Wide-field fundus image from infant ROP screening. Image size 1440x1080. 130° field of view (Natus RetCam Envision) — 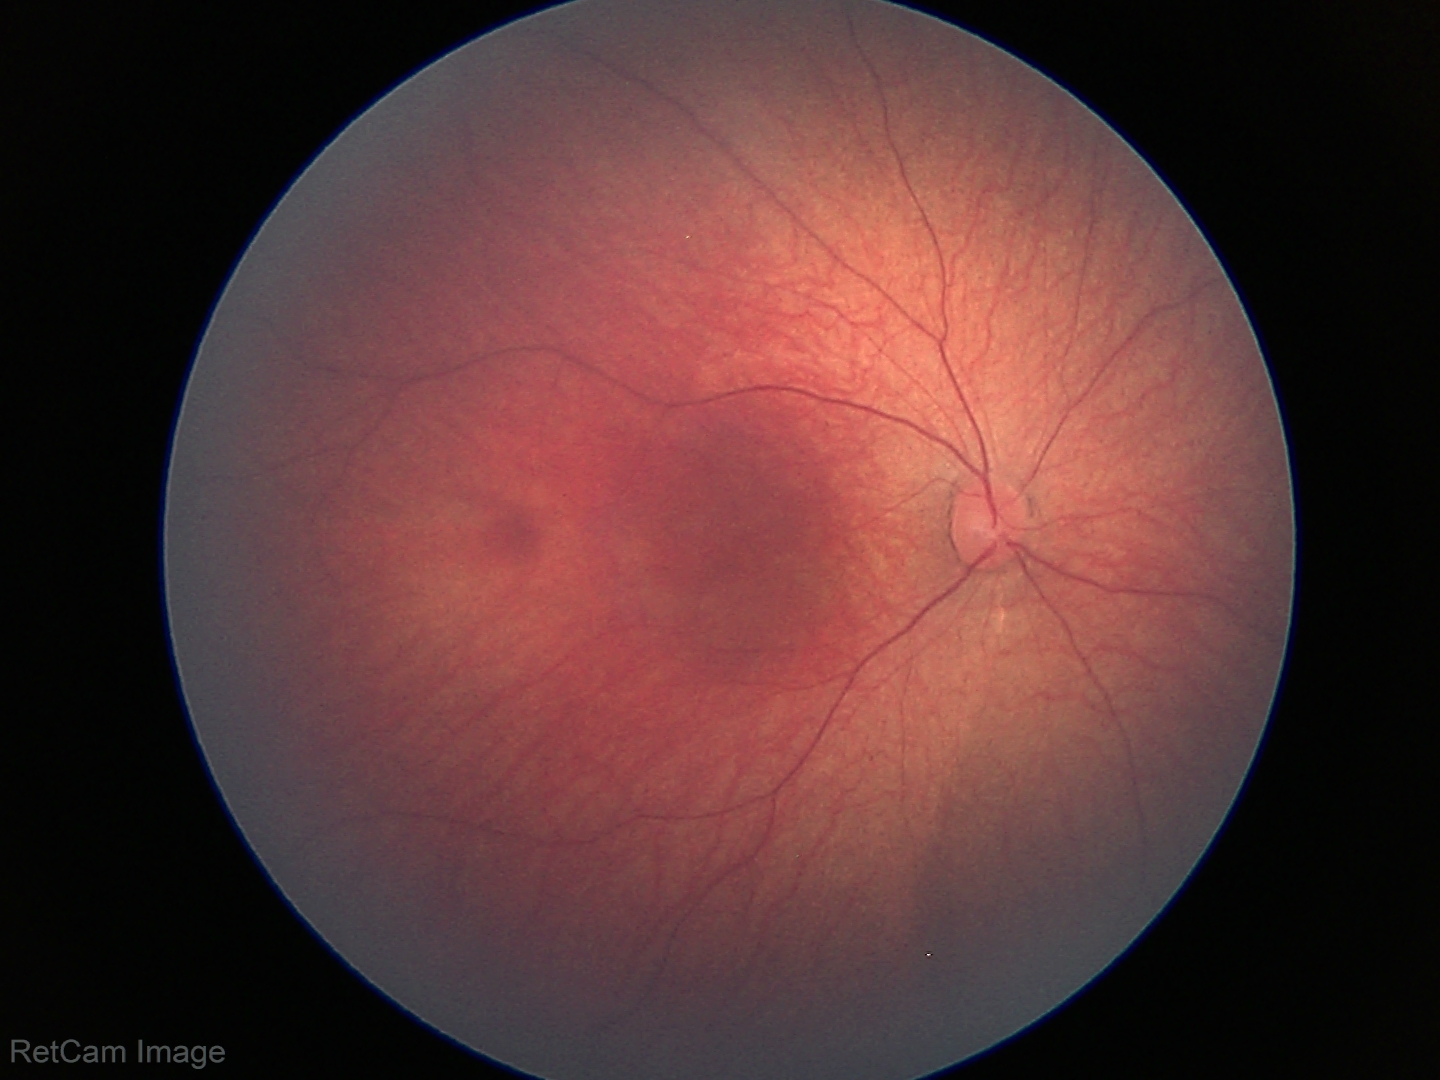
Q: What was the screening finding?
A: physiological finding